1659 x 2212 pixels.
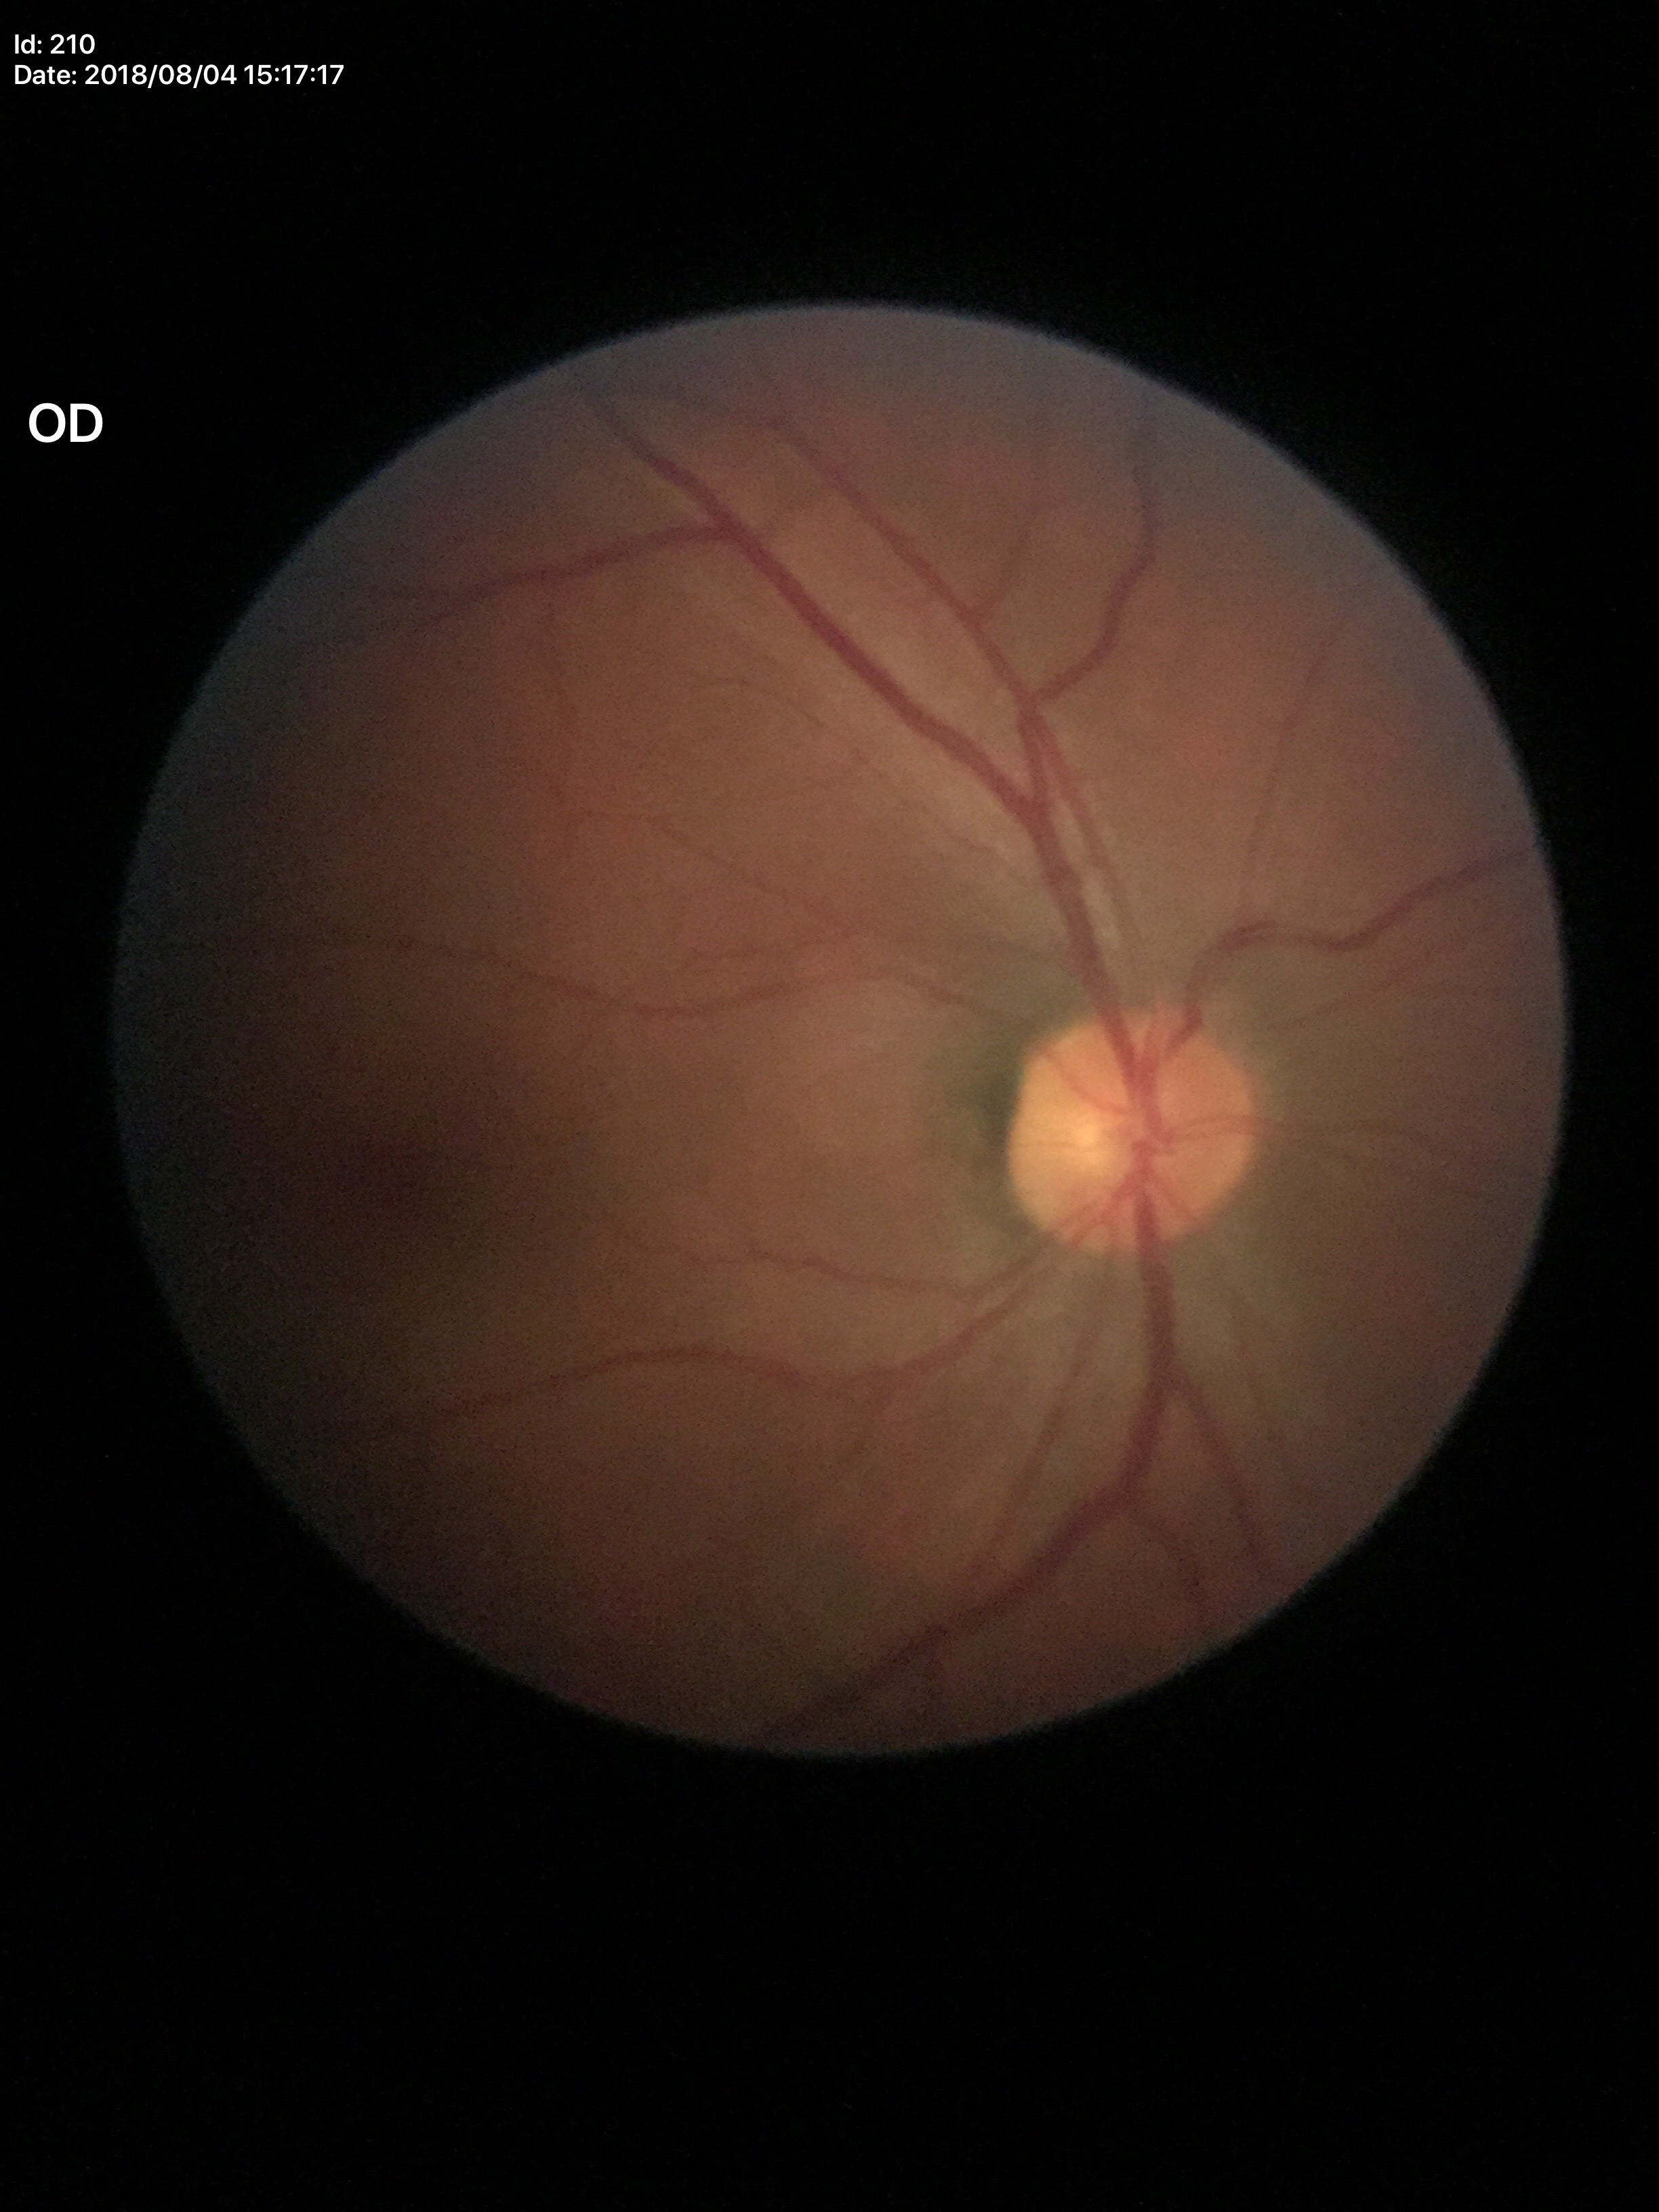

Glaucoma screening: negative. Vertical CDR of 0.45. Horizontal C/D ratio is 0.47.